No pharmacologic dilation · 45° FOV · image size 848x848.
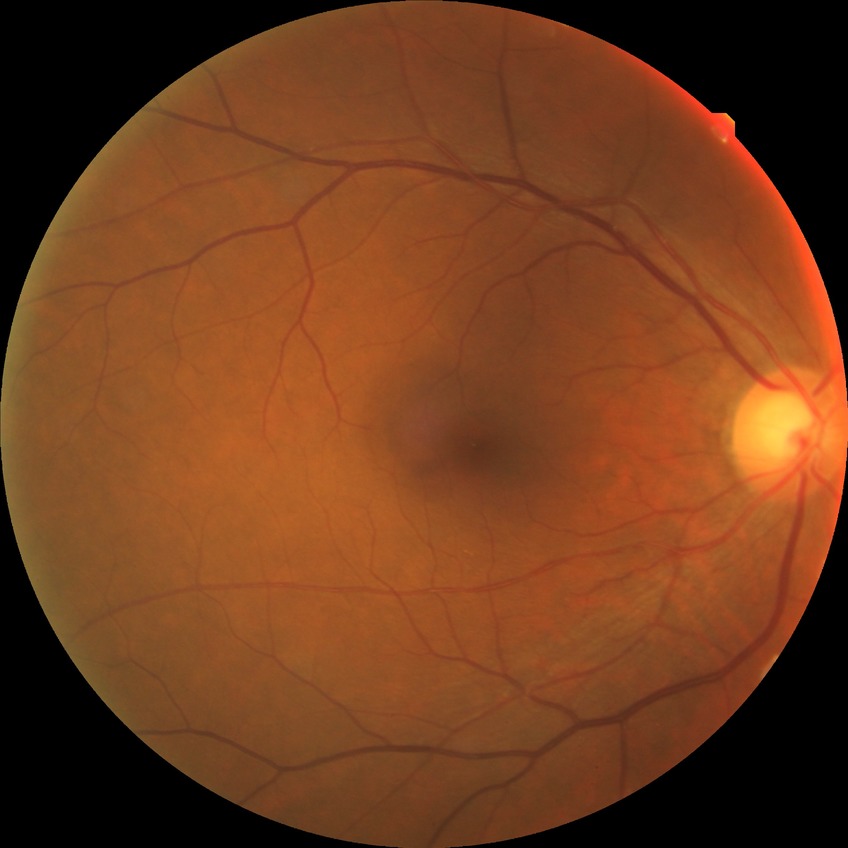 Findings:
– diabetic retinopathy (DR) — NDR (no diabetic retinopathy)